Captured with the Clarity RetCam 3 (130° field of view) · pediatric retinal photograph (wide-field): 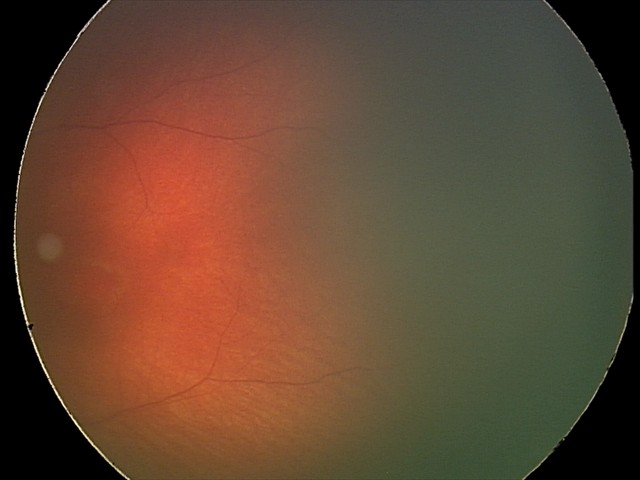

Screening examination diagnosed as physiological.